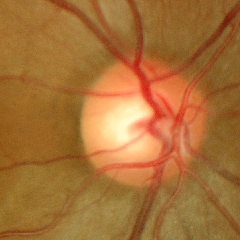

Color fundus photograph showing no glaucomatous findings.